640x480. 130° field of view (Clarity RetCam 3). Infant wide-field retinal image — 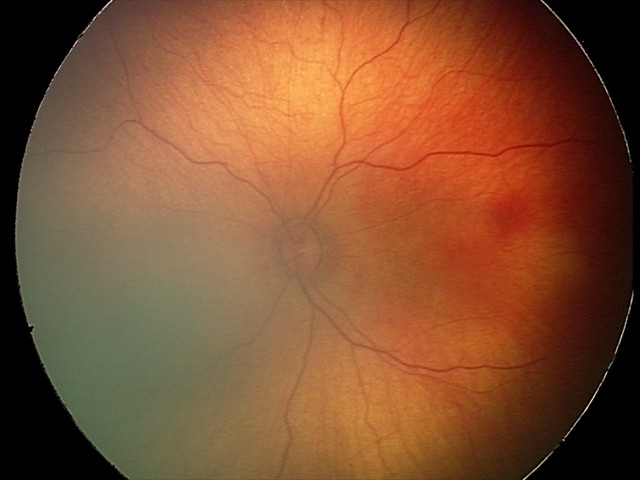 Screening examination with no abnormal retinal findings.